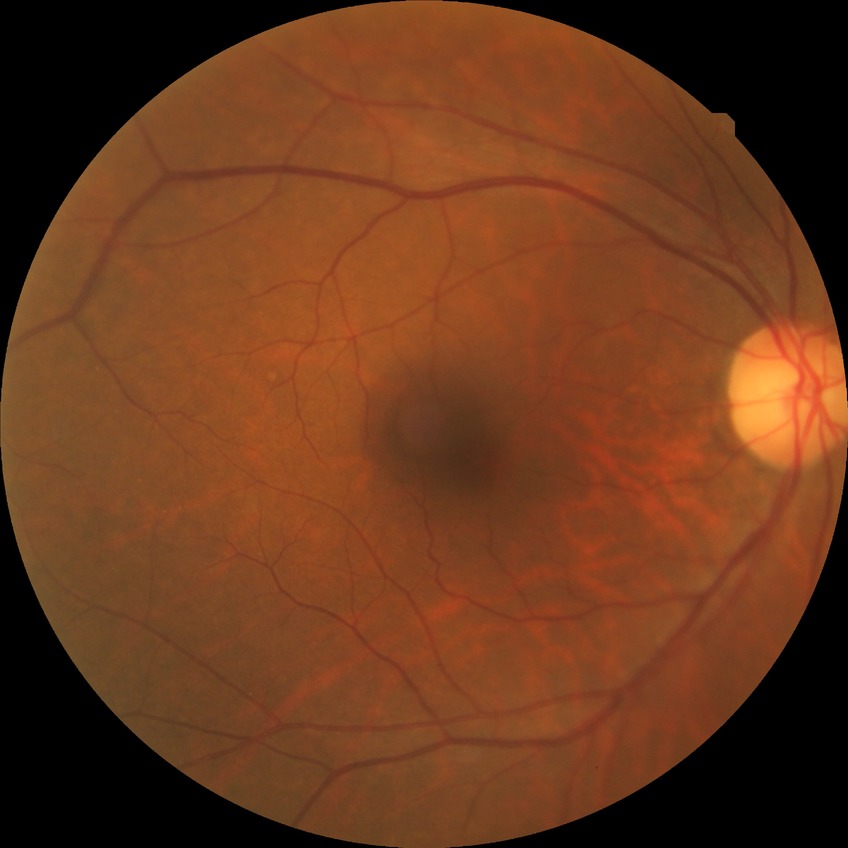
Diabetic retinopathy (DR) is NDR (no diabetic retinopathy).